FOV: 200 degrees — 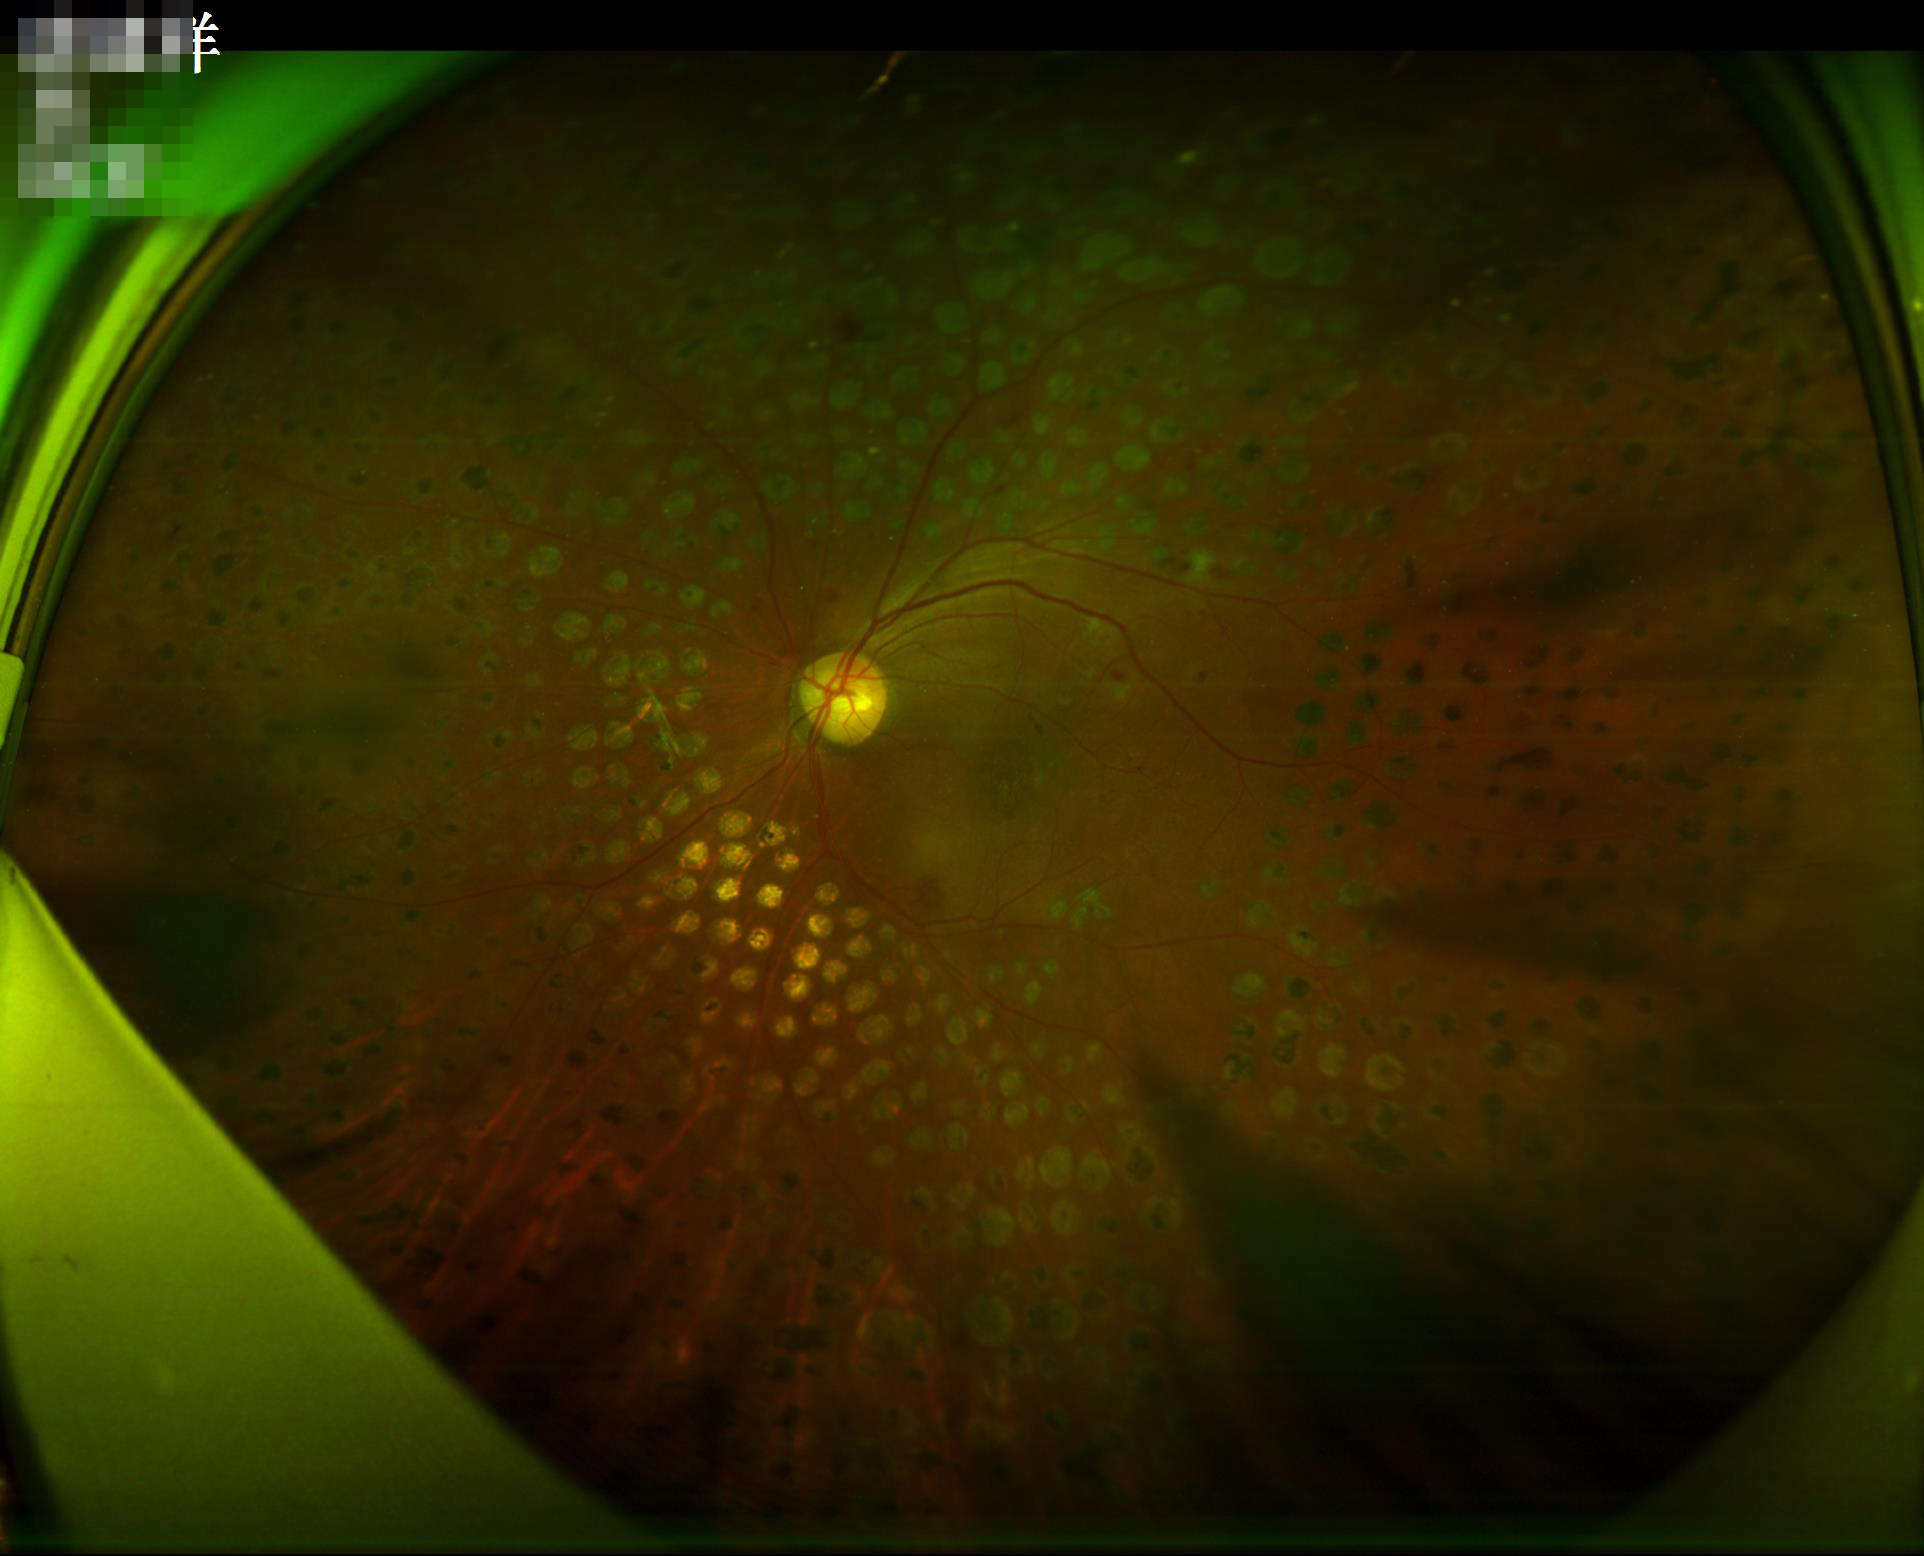
Overall quality is poor; the image is difficult to grade. There is over- or under-exposure or a color cast. Noticeable blur in the optic disc, vessels, or background. Adequate contrast for distinguishing structures.